Davis DR grading: 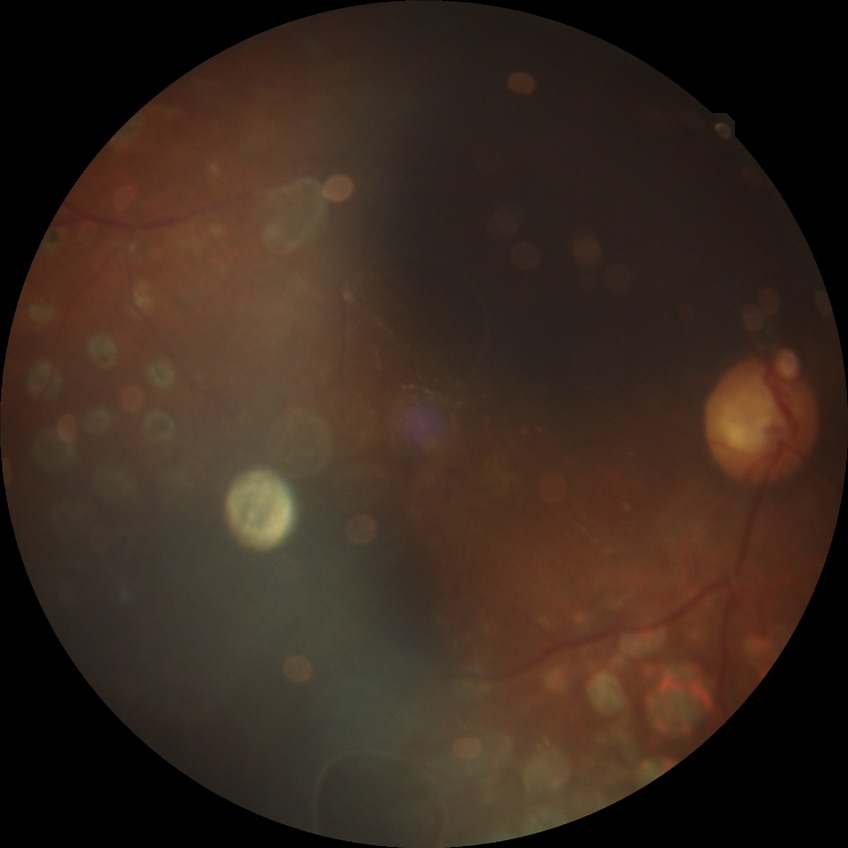
diabetic retinopathy (DR): PDR (proliferative diabetic retinopathy)